FOV: 45 degrees, fundus photo — 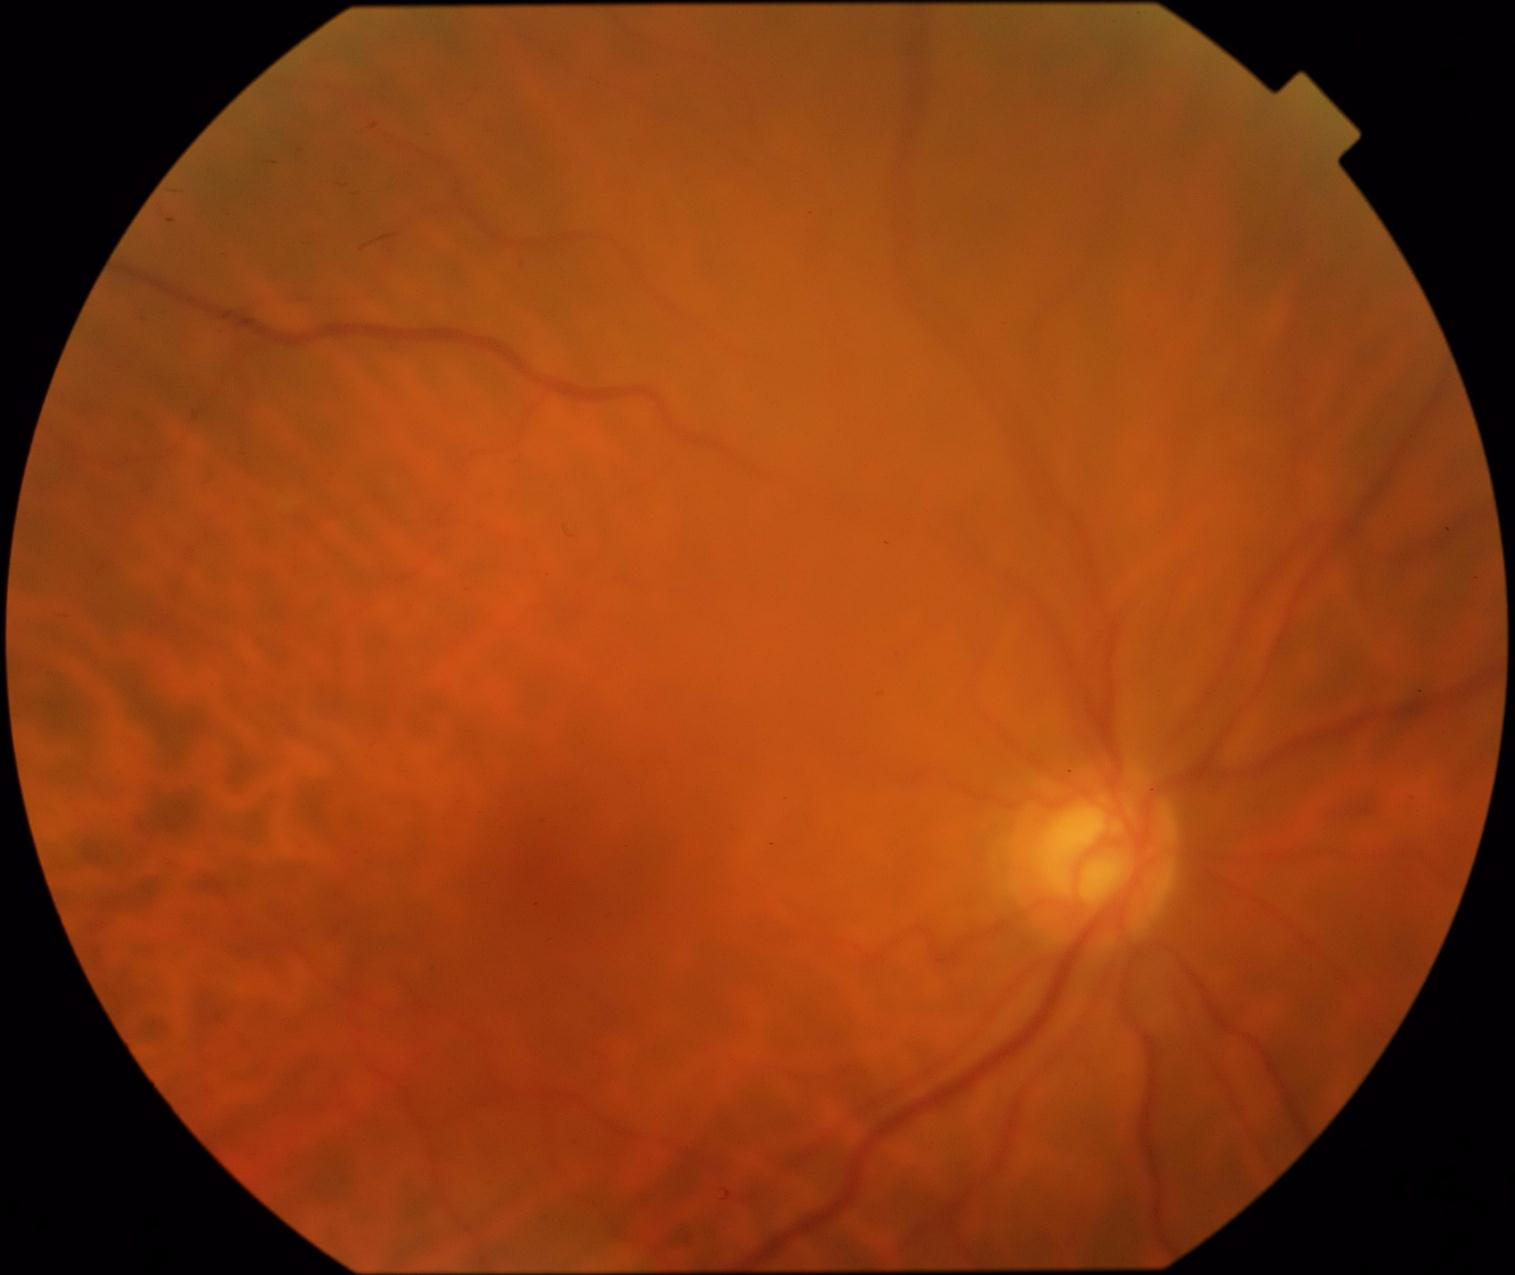
Retinopathy grade is 0 (no apparent retinopathy).
No apparent diabetic retinopathy.